Phoenix ICON, 100° FOV · 1240x1240 · wide-field fundus photograph from neonatal ROP screening: 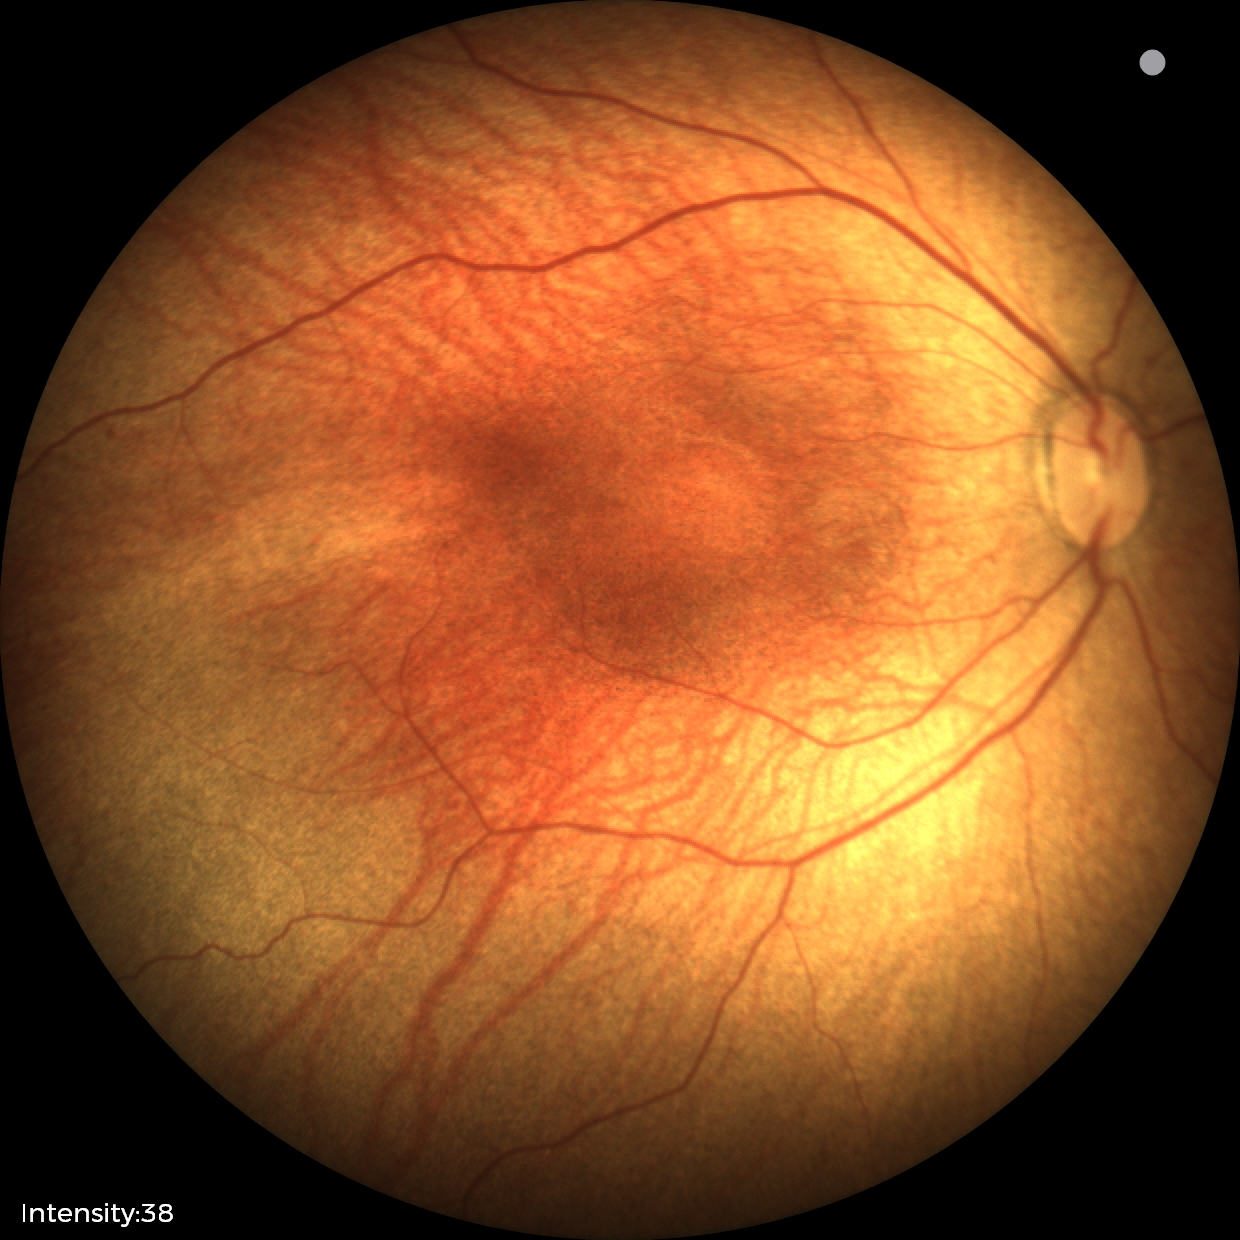
Examination diagnosed as status post ROP.
No plus disease.